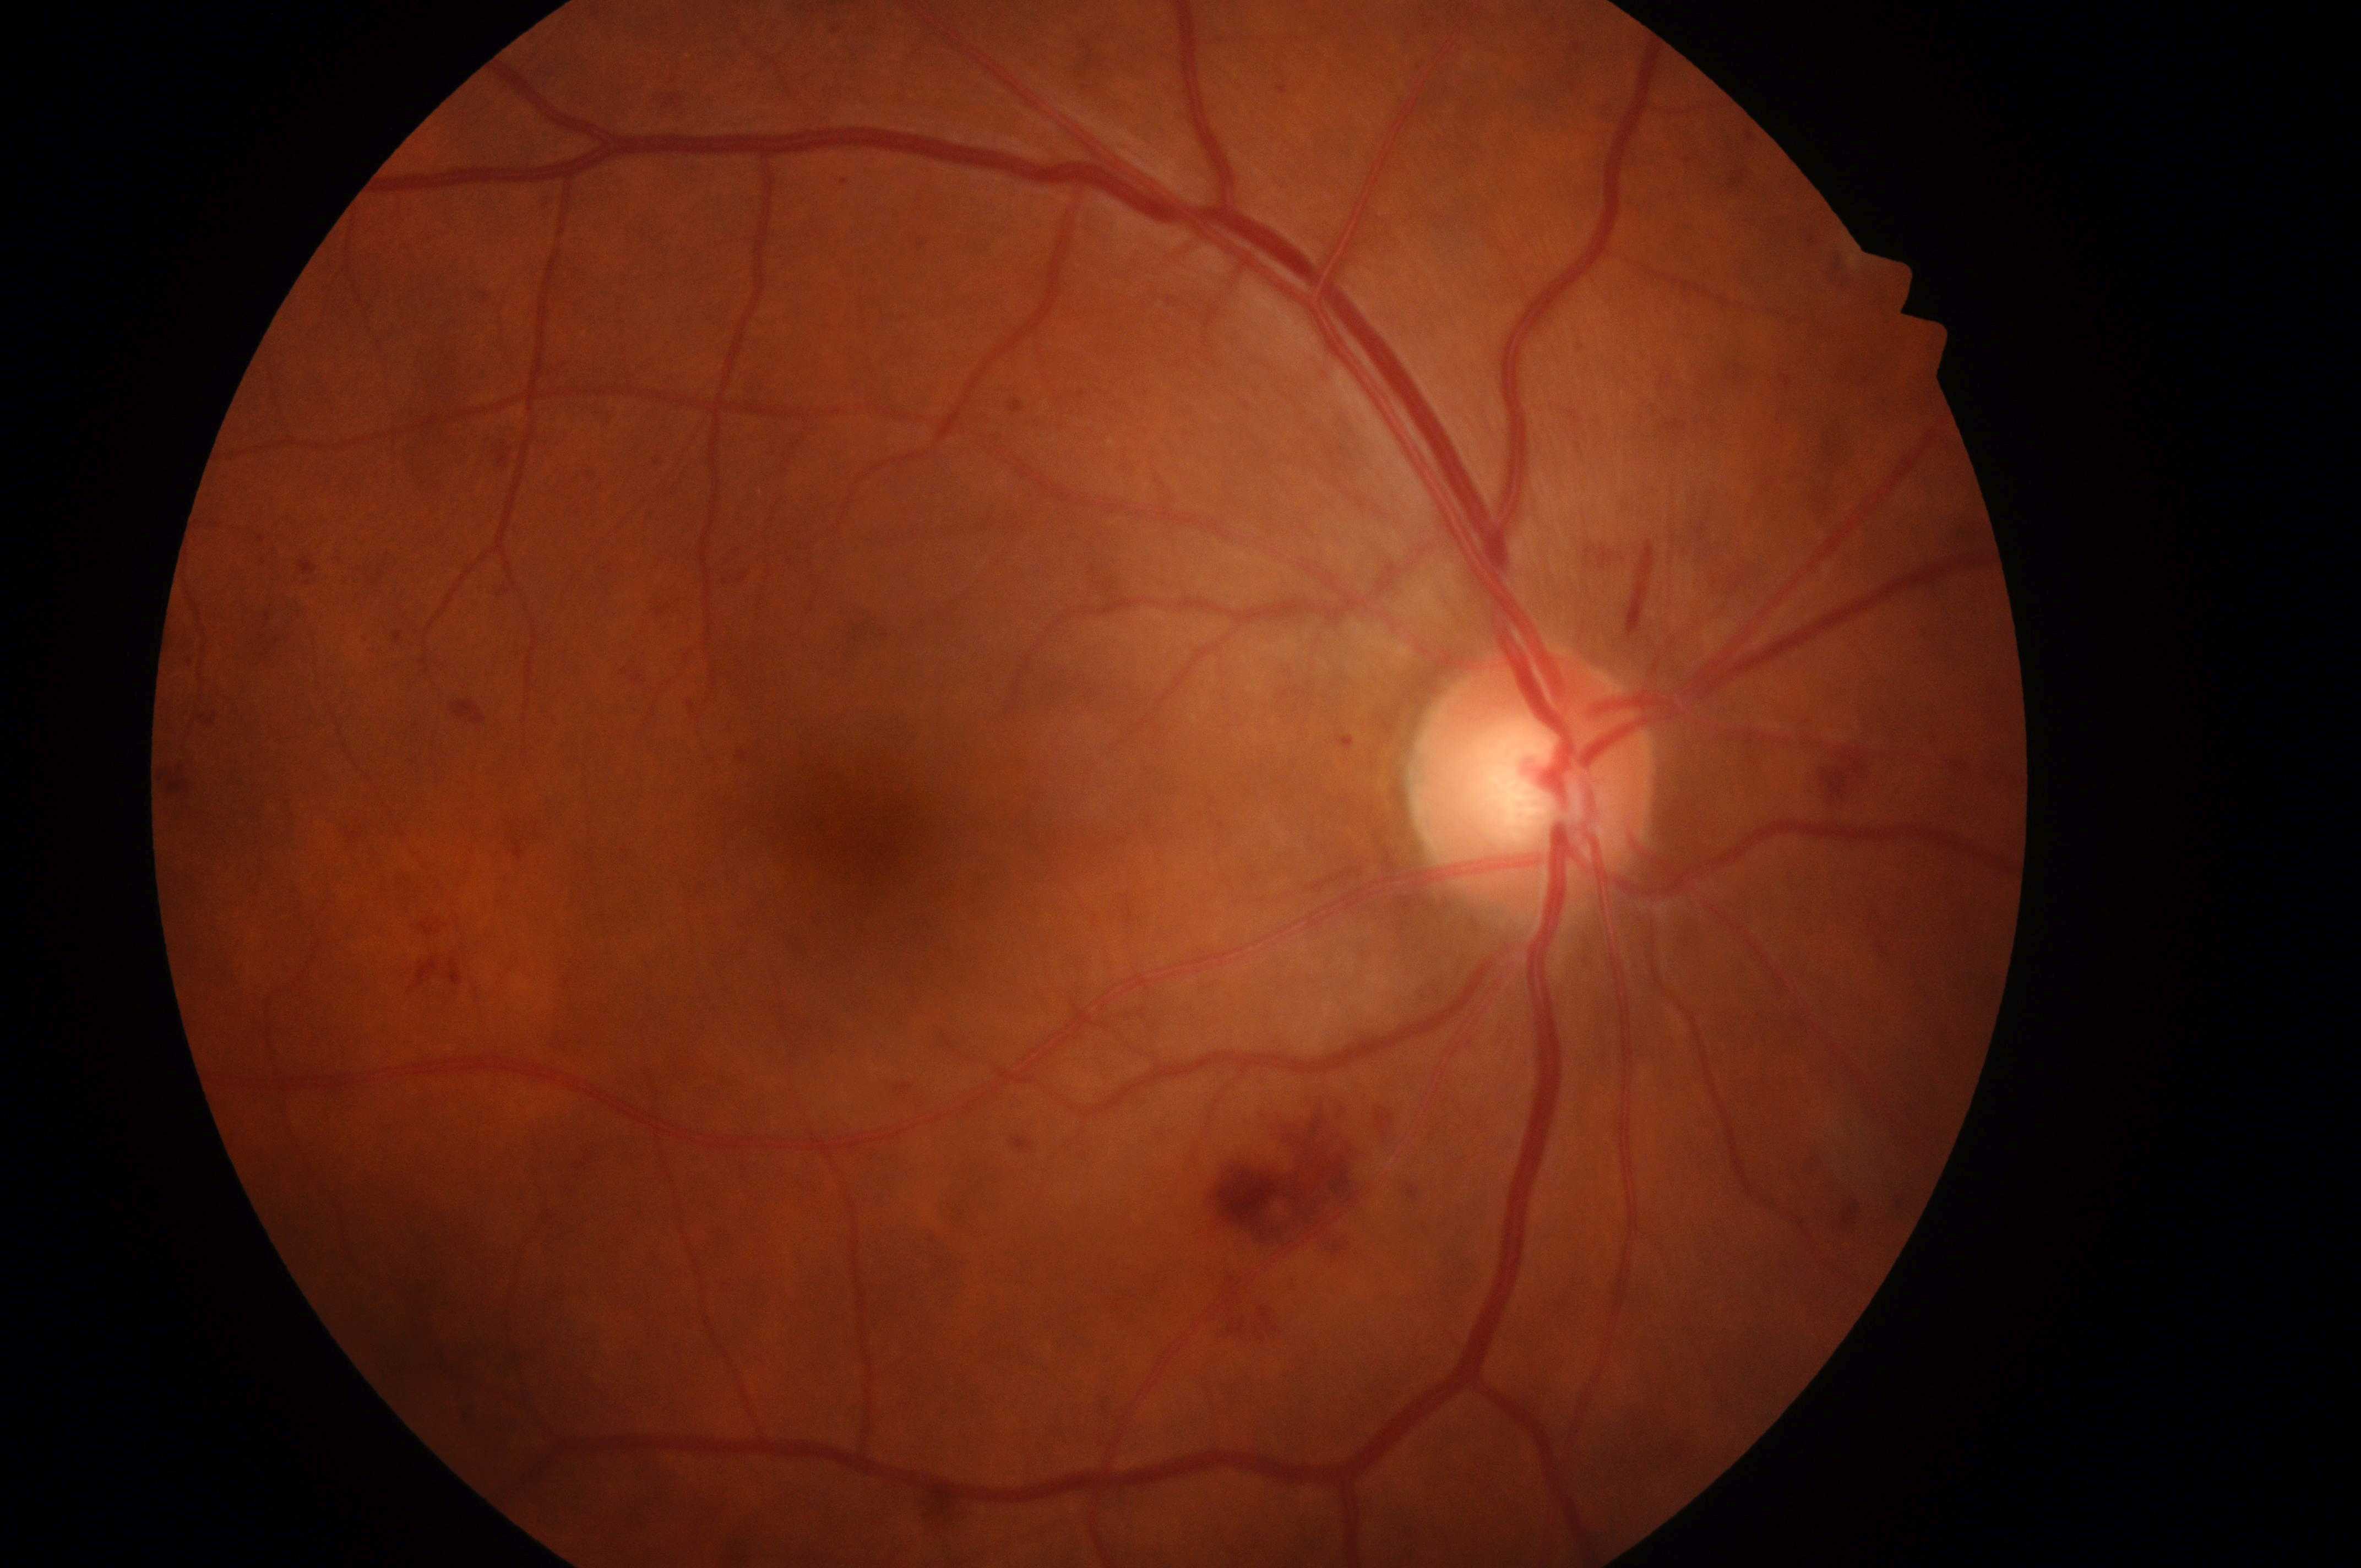
Imaged eye: oculus dexter. The fovea is at (x=872, y=837). Diabetic retinopathy grade is 2/4. Optic nerve head: (x=1532, y=793). Risk of macular edema: grade 0.